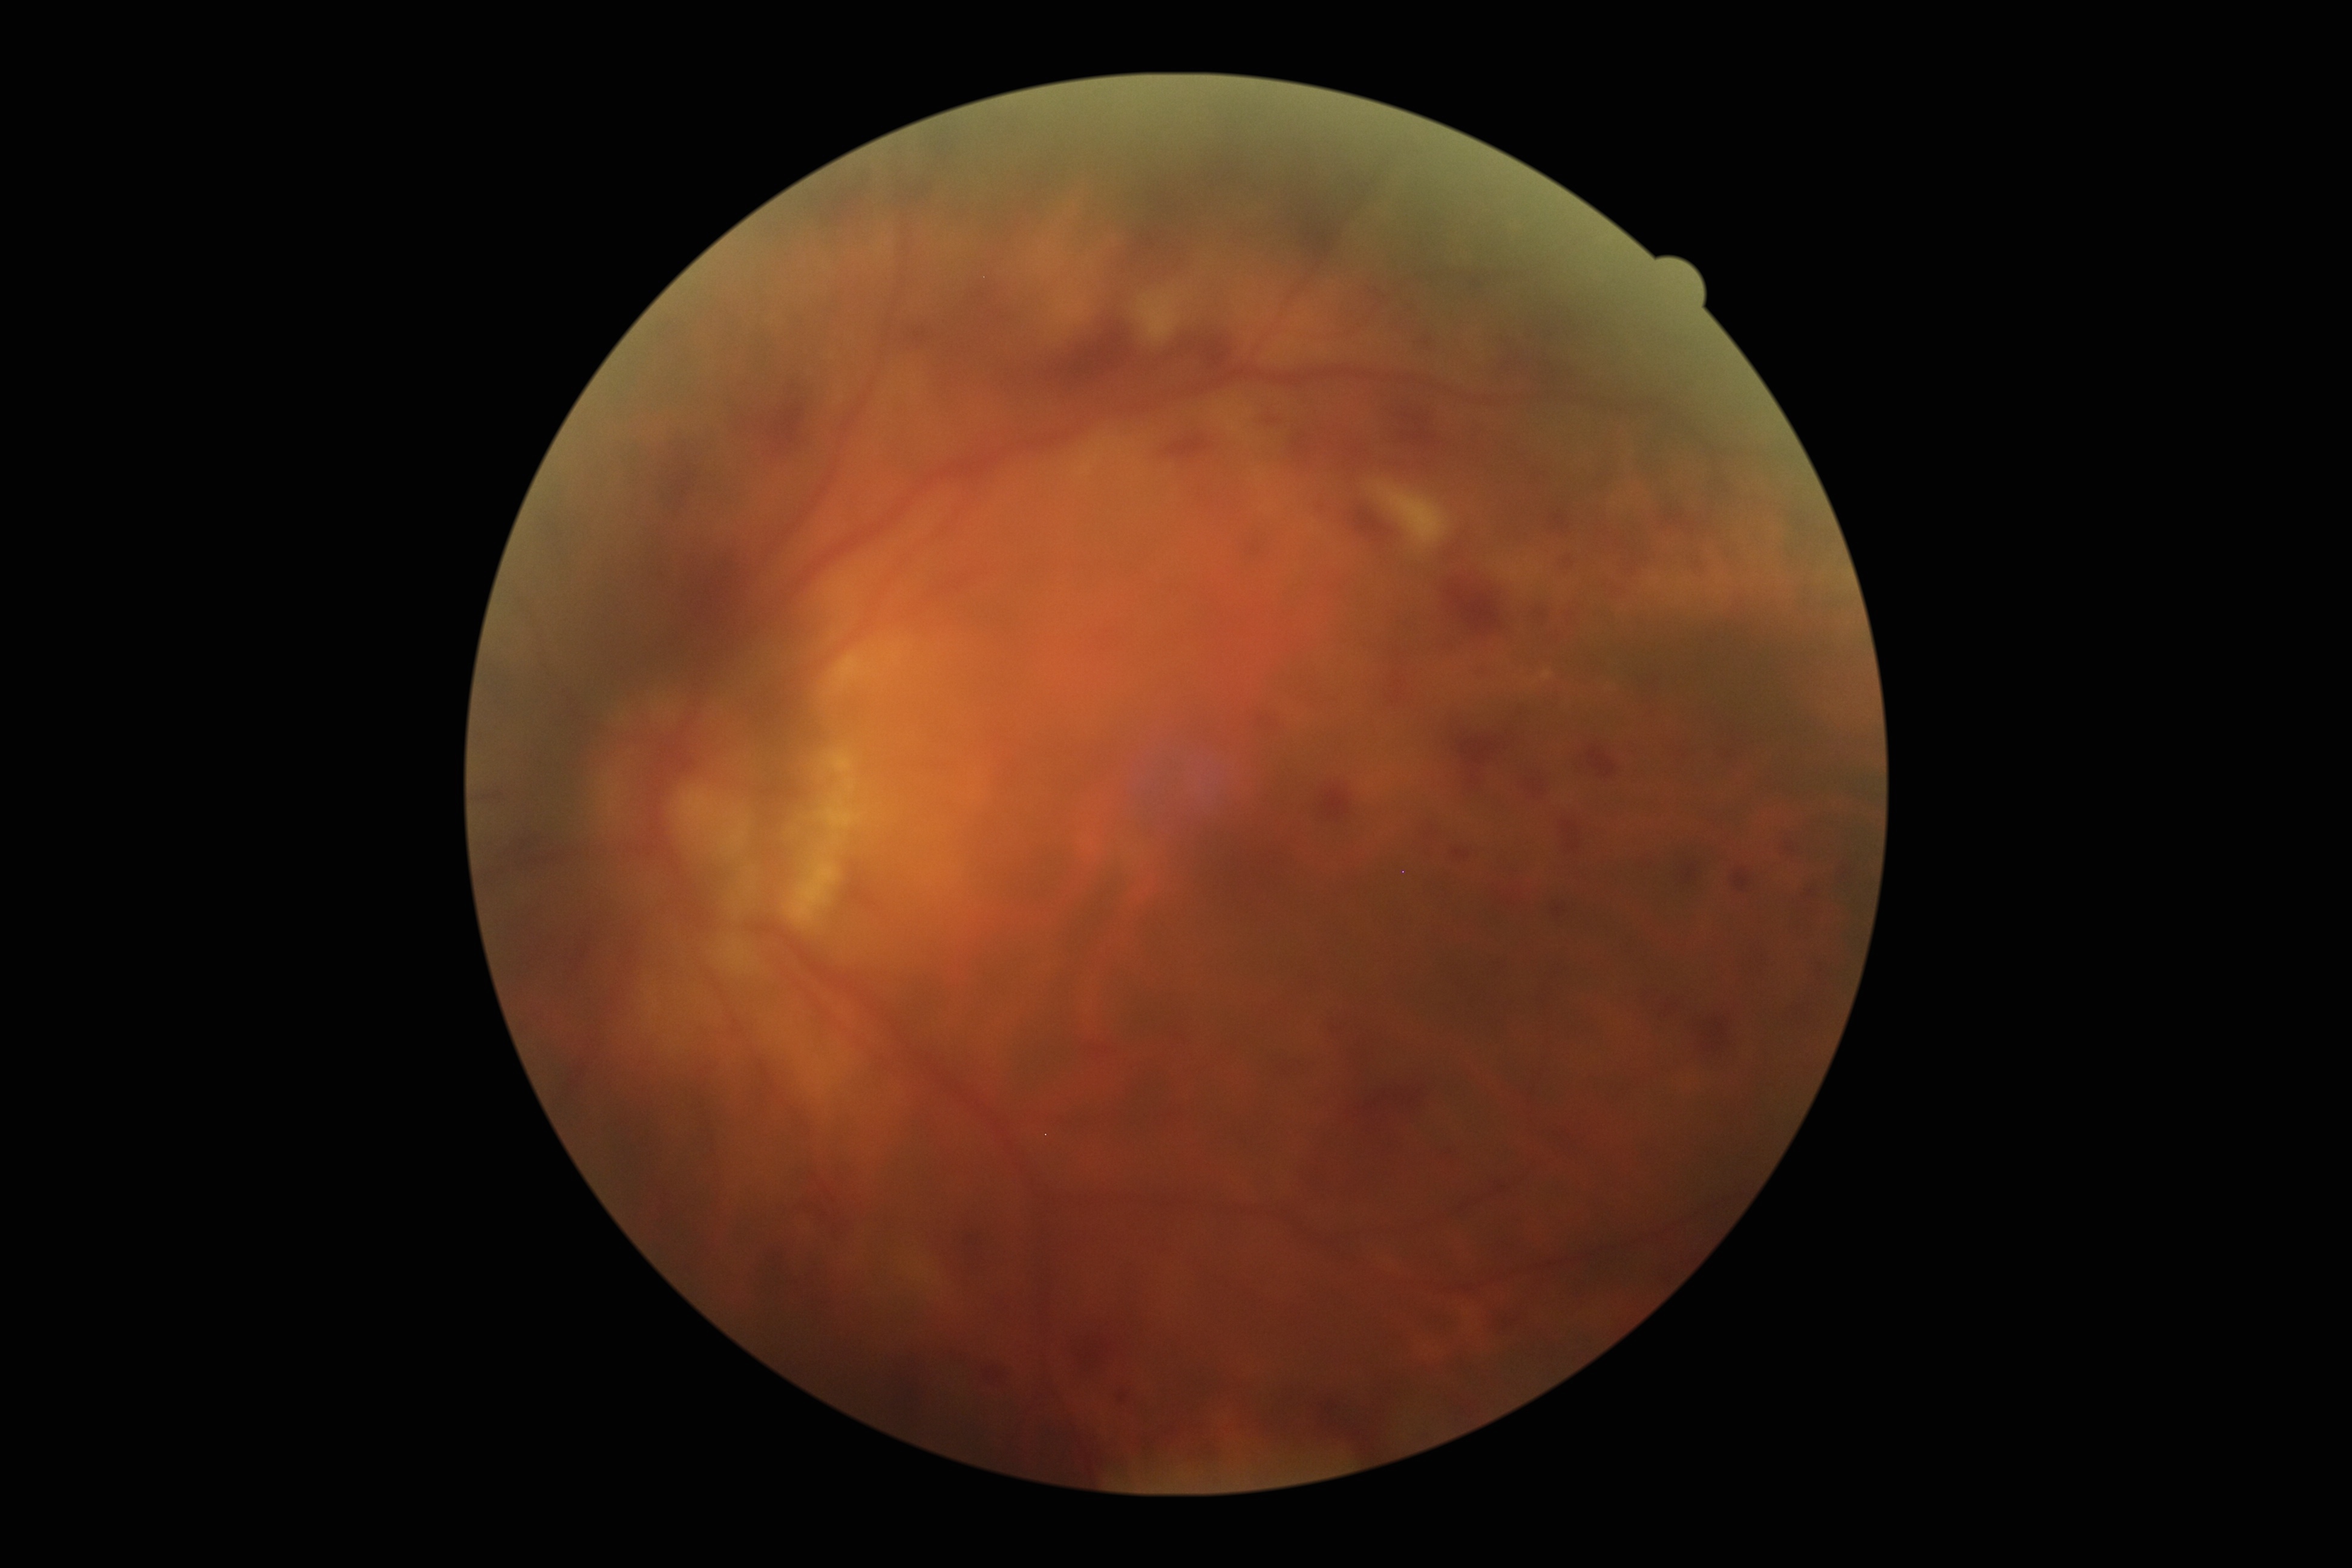
DR grade is 3/4.